Color fundus photograph:
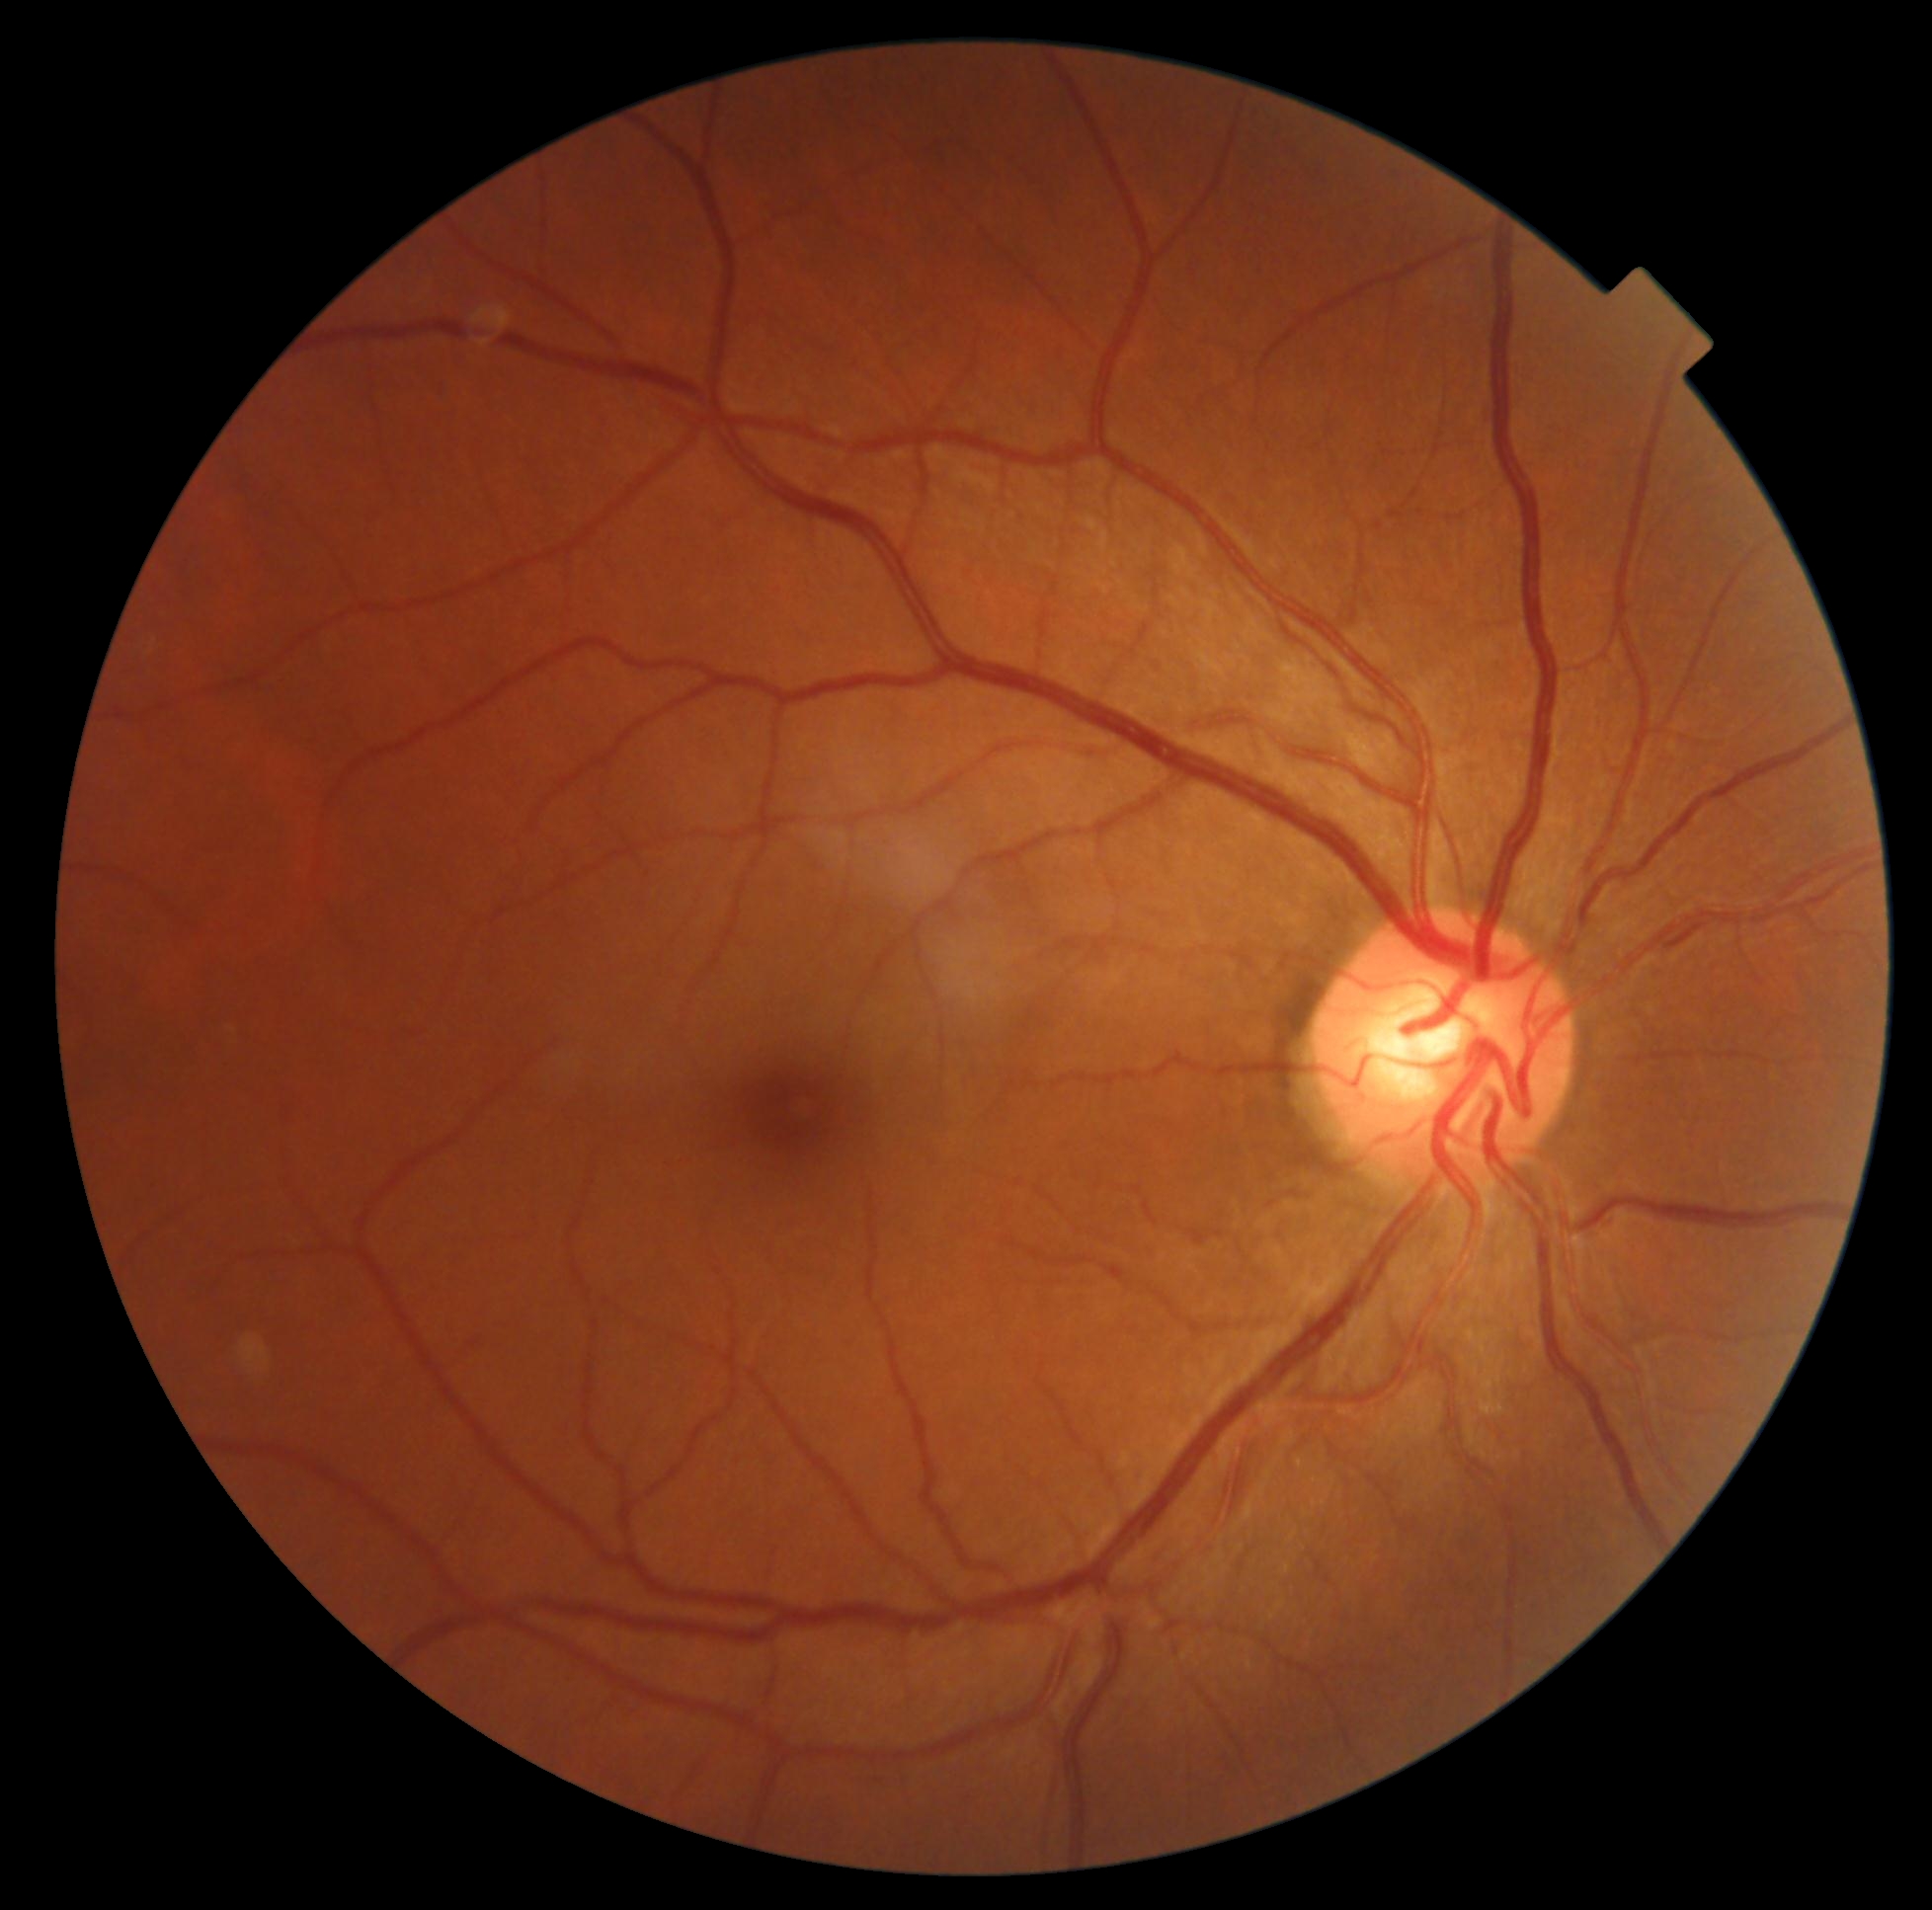

Diabetic retinopathy (DR) is 0/4.
No diabetic retinal disease findings.